Color fundus image · 2048x1536
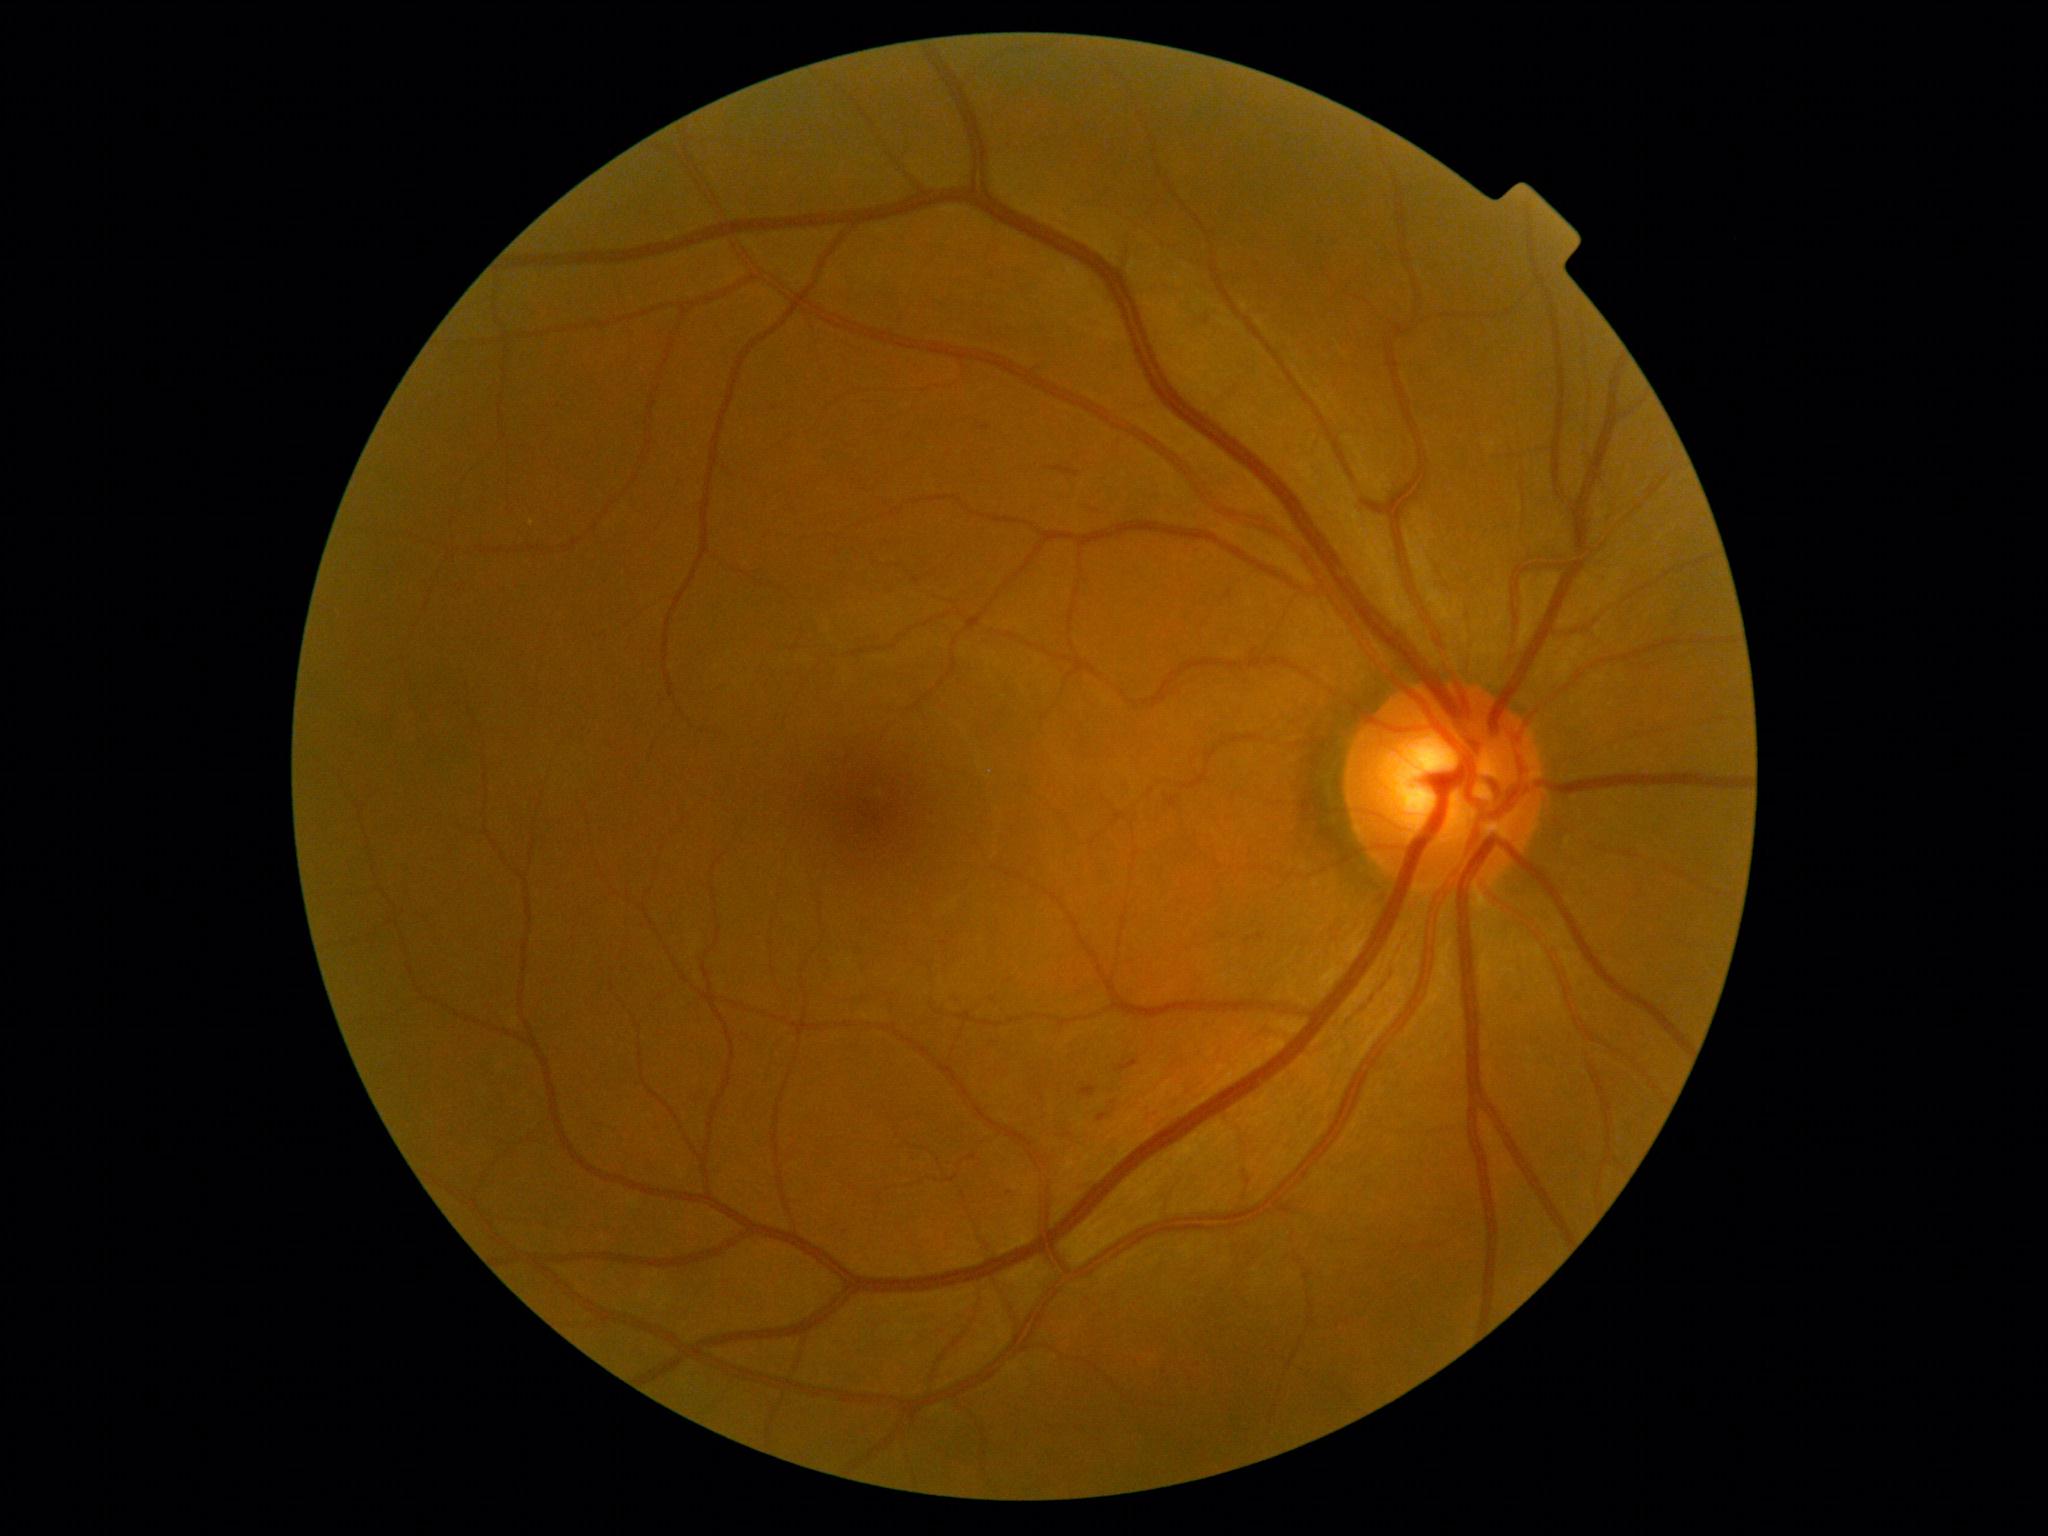 Retinopathy grade: 2 (moderate NPDR) — more than just microaneurysms but less than severe NPDR.